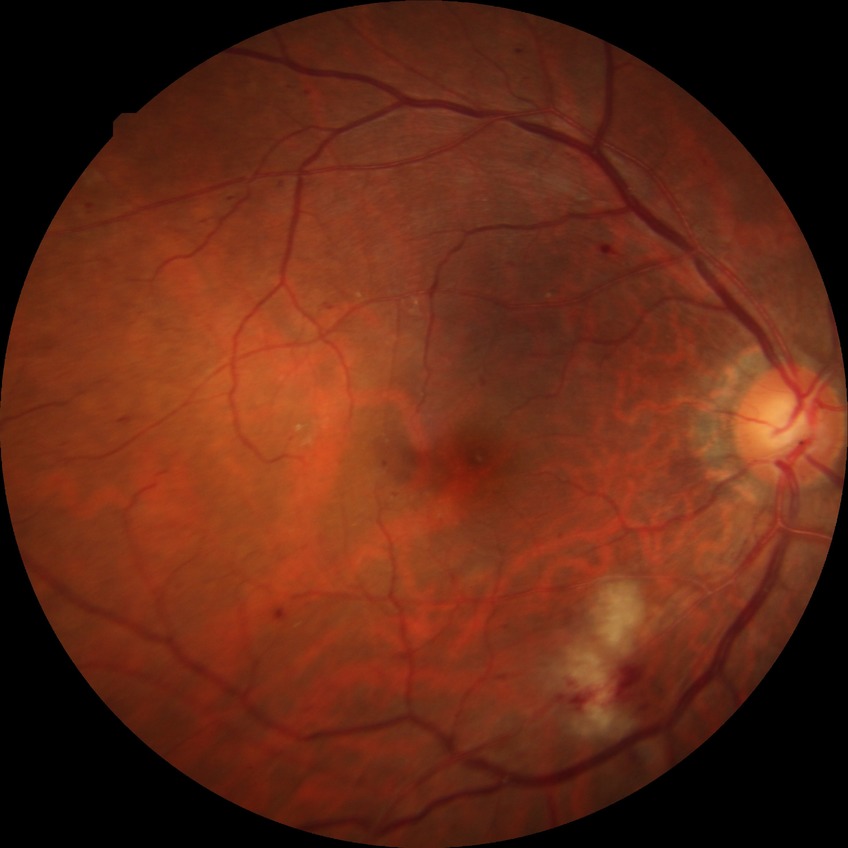 Retinopathy grade: pre-proliferative diabetic retinopathy.